DR severity per modified Davis staging:
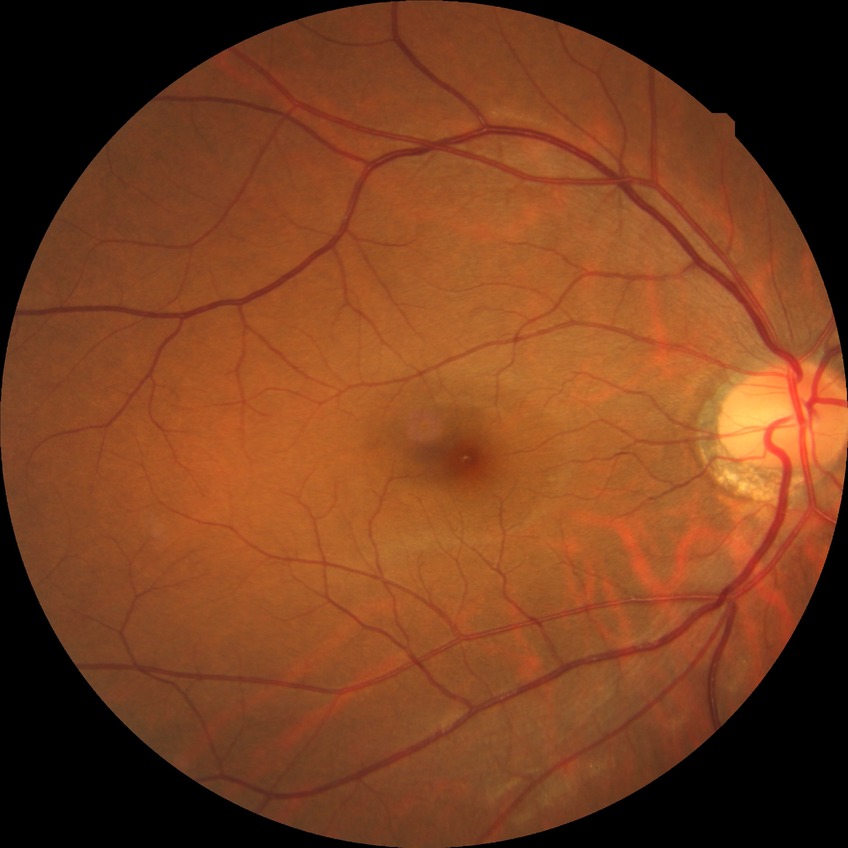 diabetic retinopathy (DR)@NDR (no diabetic retinopathy).